Infant wide-field fundus photograph — 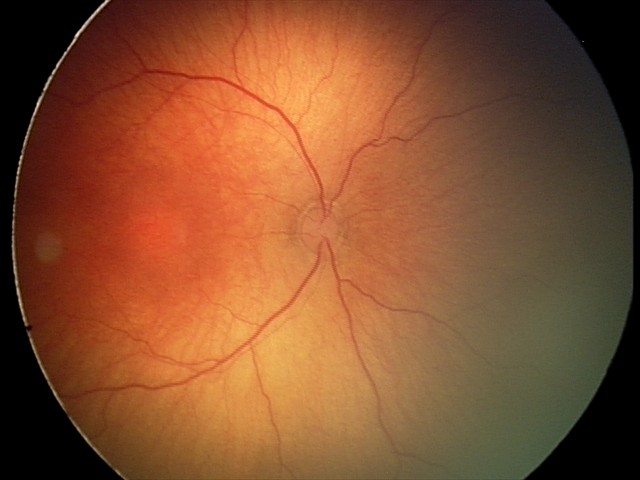

Plus disease absent. Series diagnosed as ROP stage 2.